1971 by 1876 pixels.
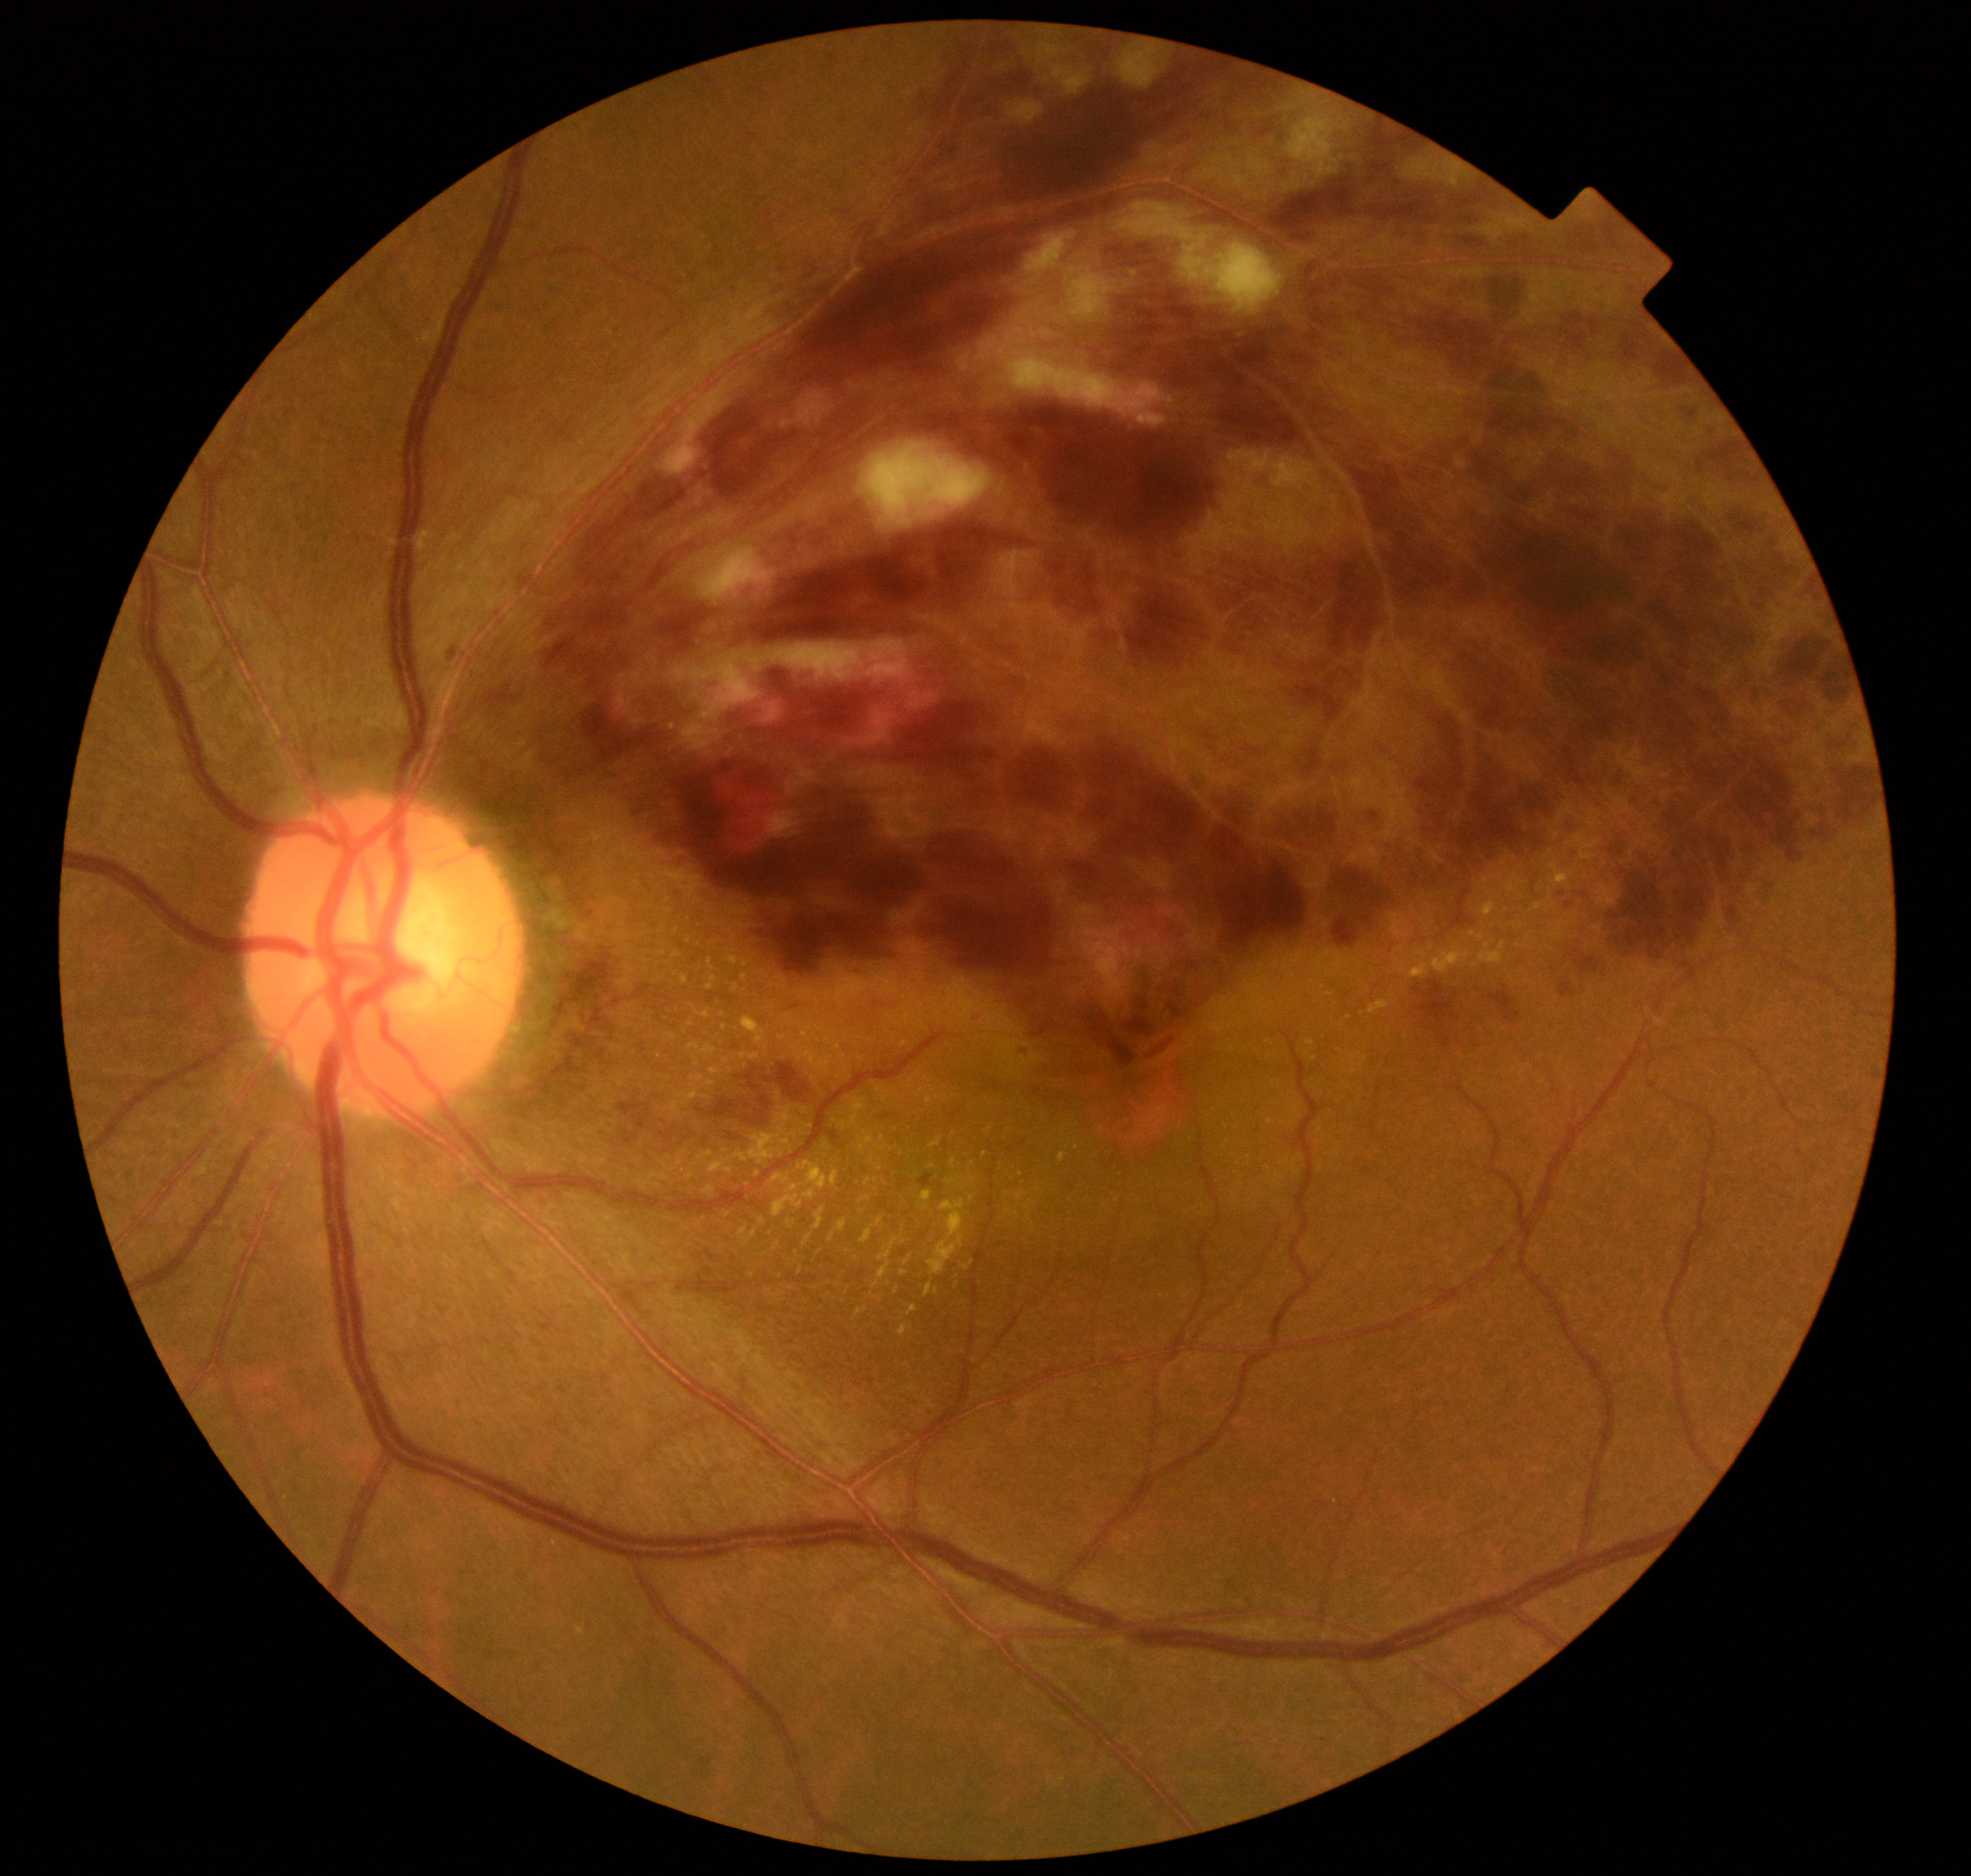
Findings: branch retinal vein occlusion. Typically showing tortuosity and dilatation of affected veins, with dot, blot, and flame hemorrhages, sometimes with cotton-wool spots or hard exudates.